Optic nerve head photograph.
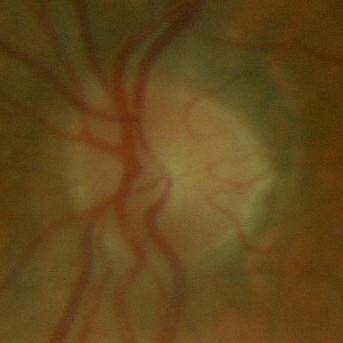

Q: Glaucoma assessment?
A: No glaucomatous findings.